50° field of view
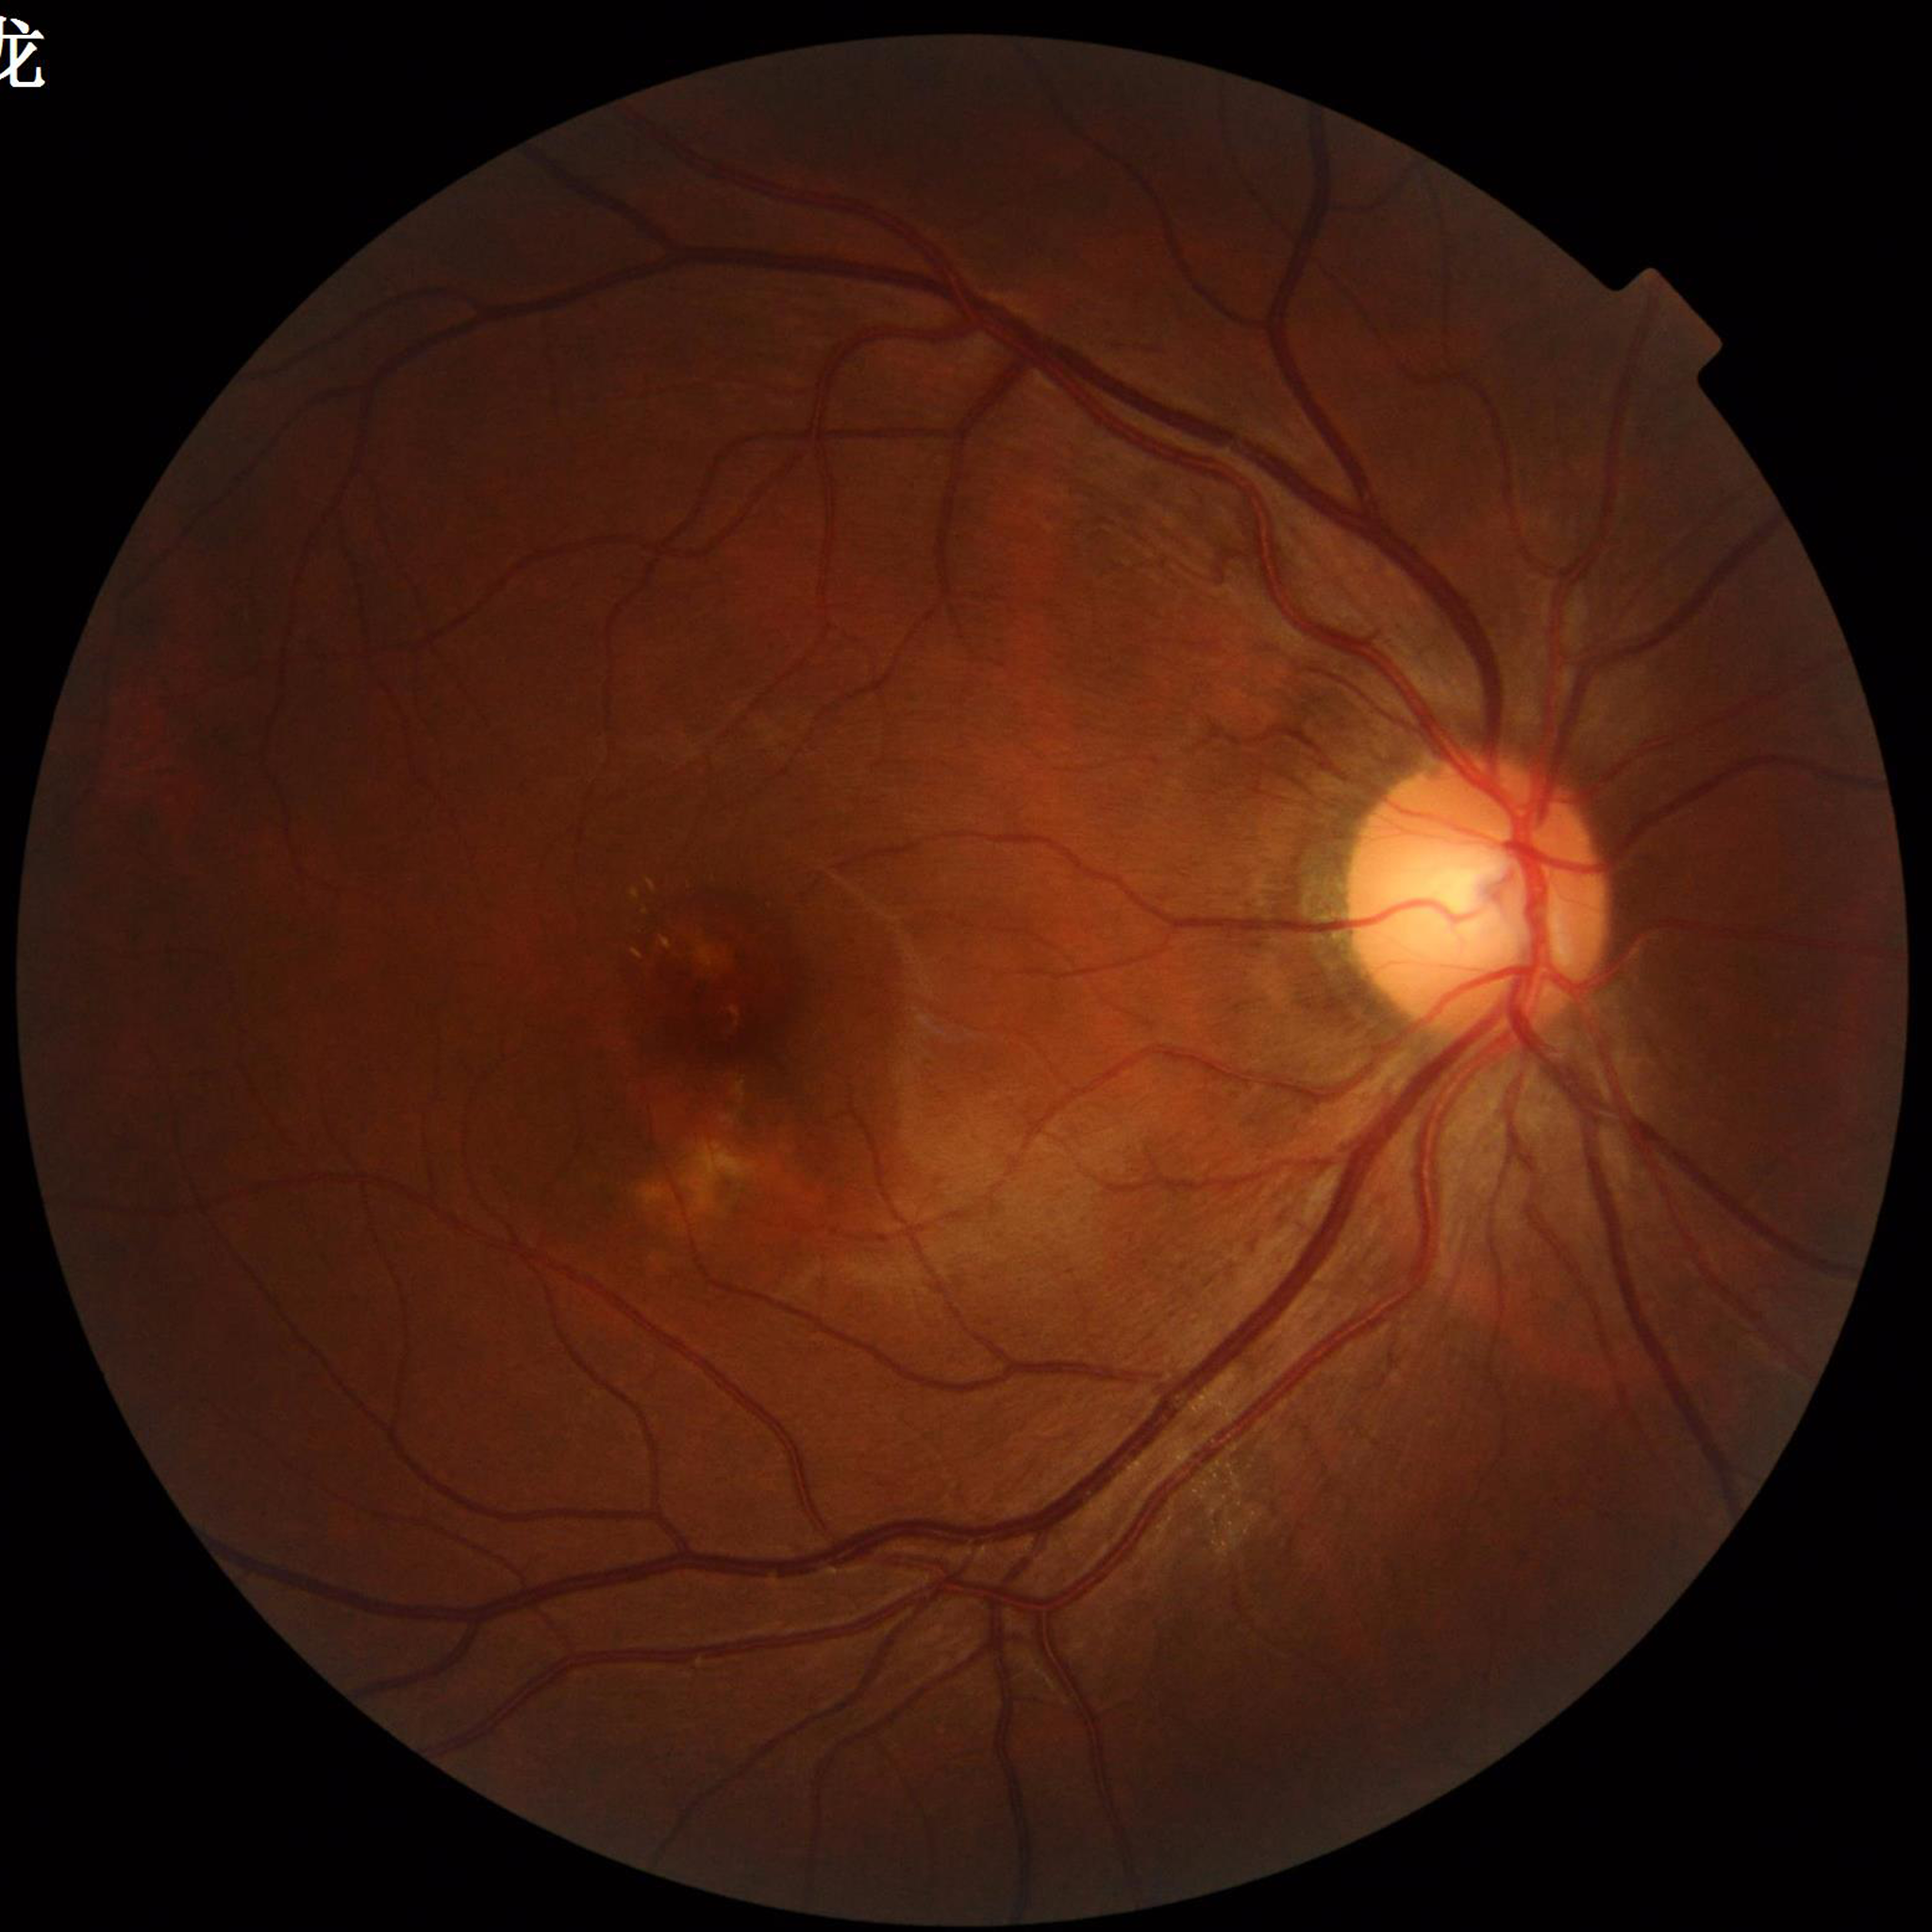
Clinical diagnosis: age-related macular degeneration
Image quality: adequate